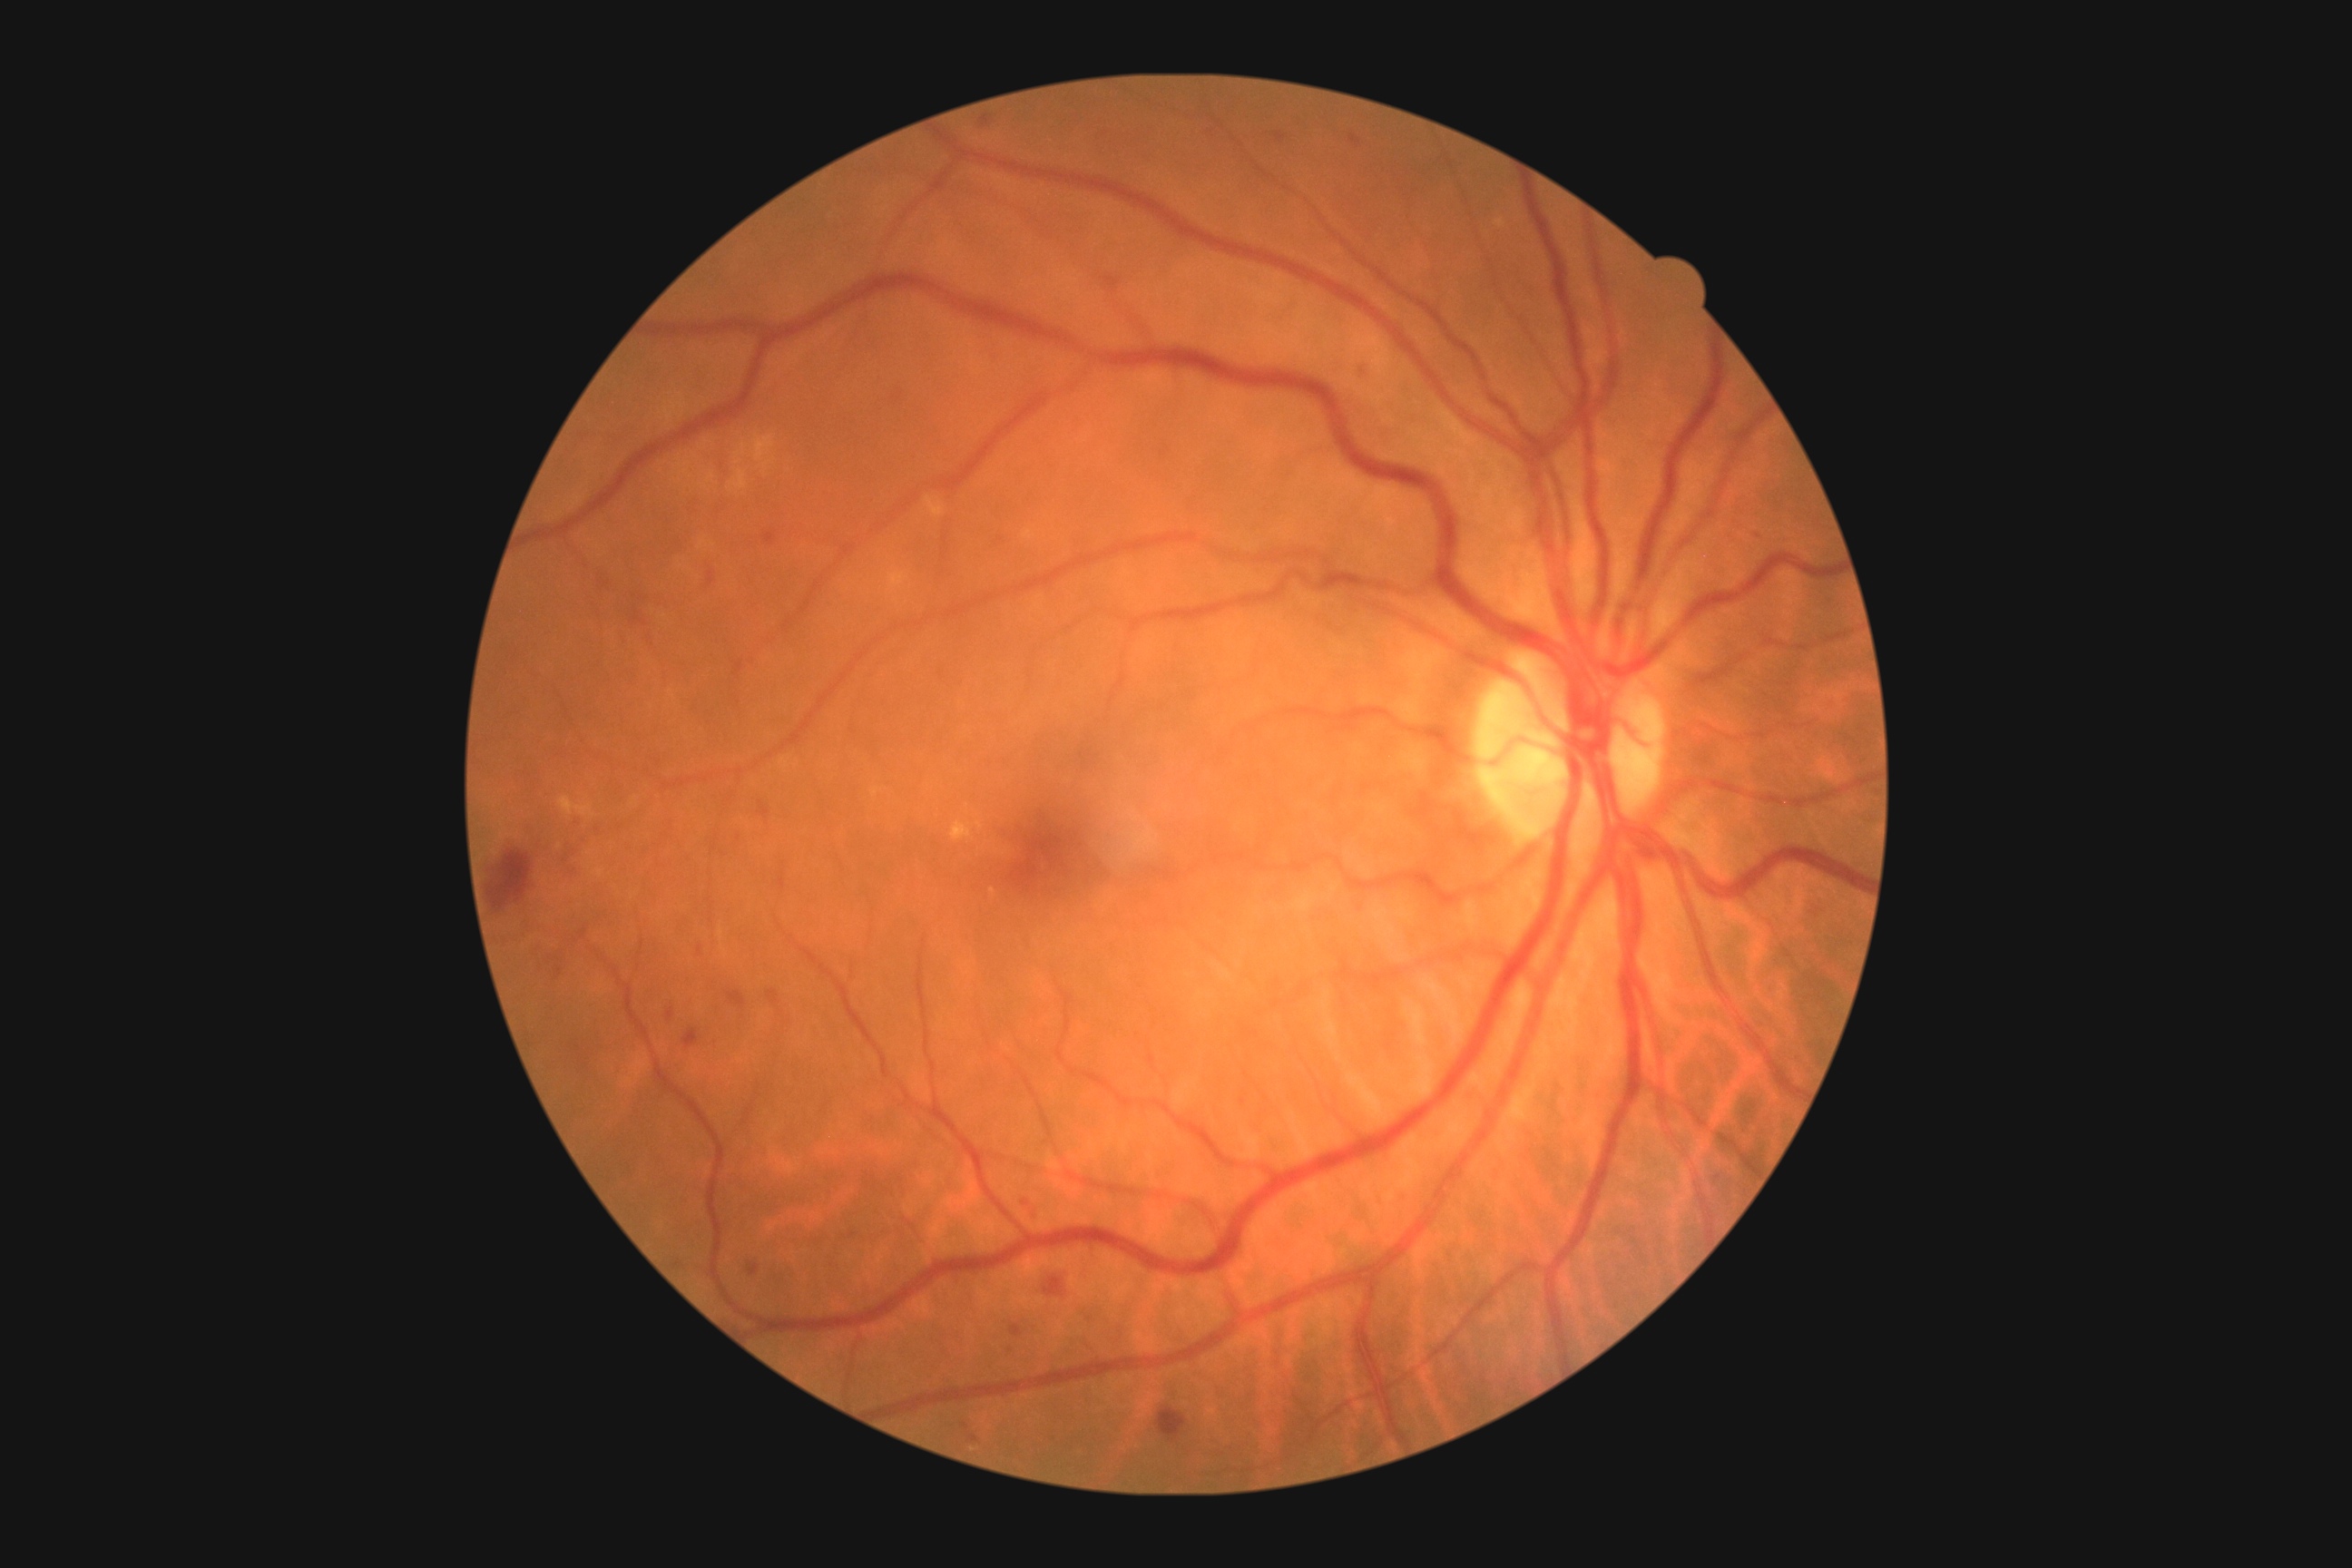
DR severity: grade 2 (moderate NPDR).
Disease class: non-proliferative diabetic retinopathy.